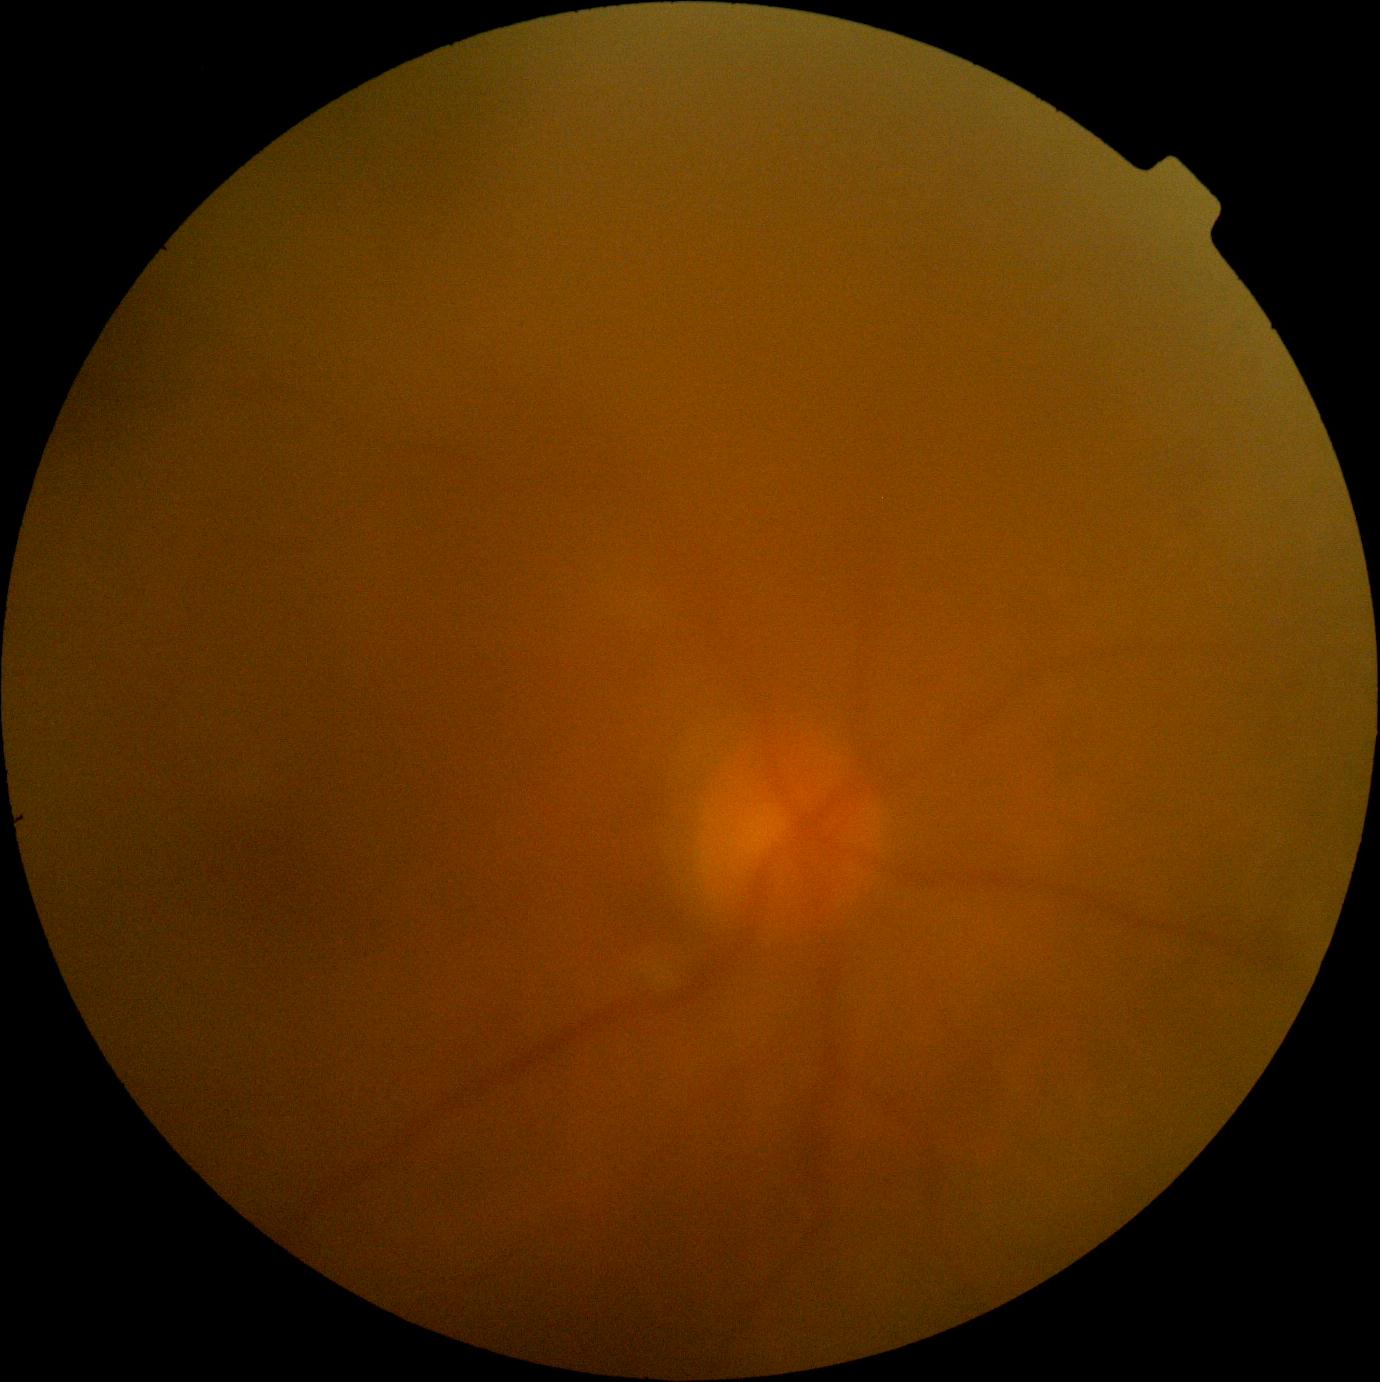 DR stage: ungradable.